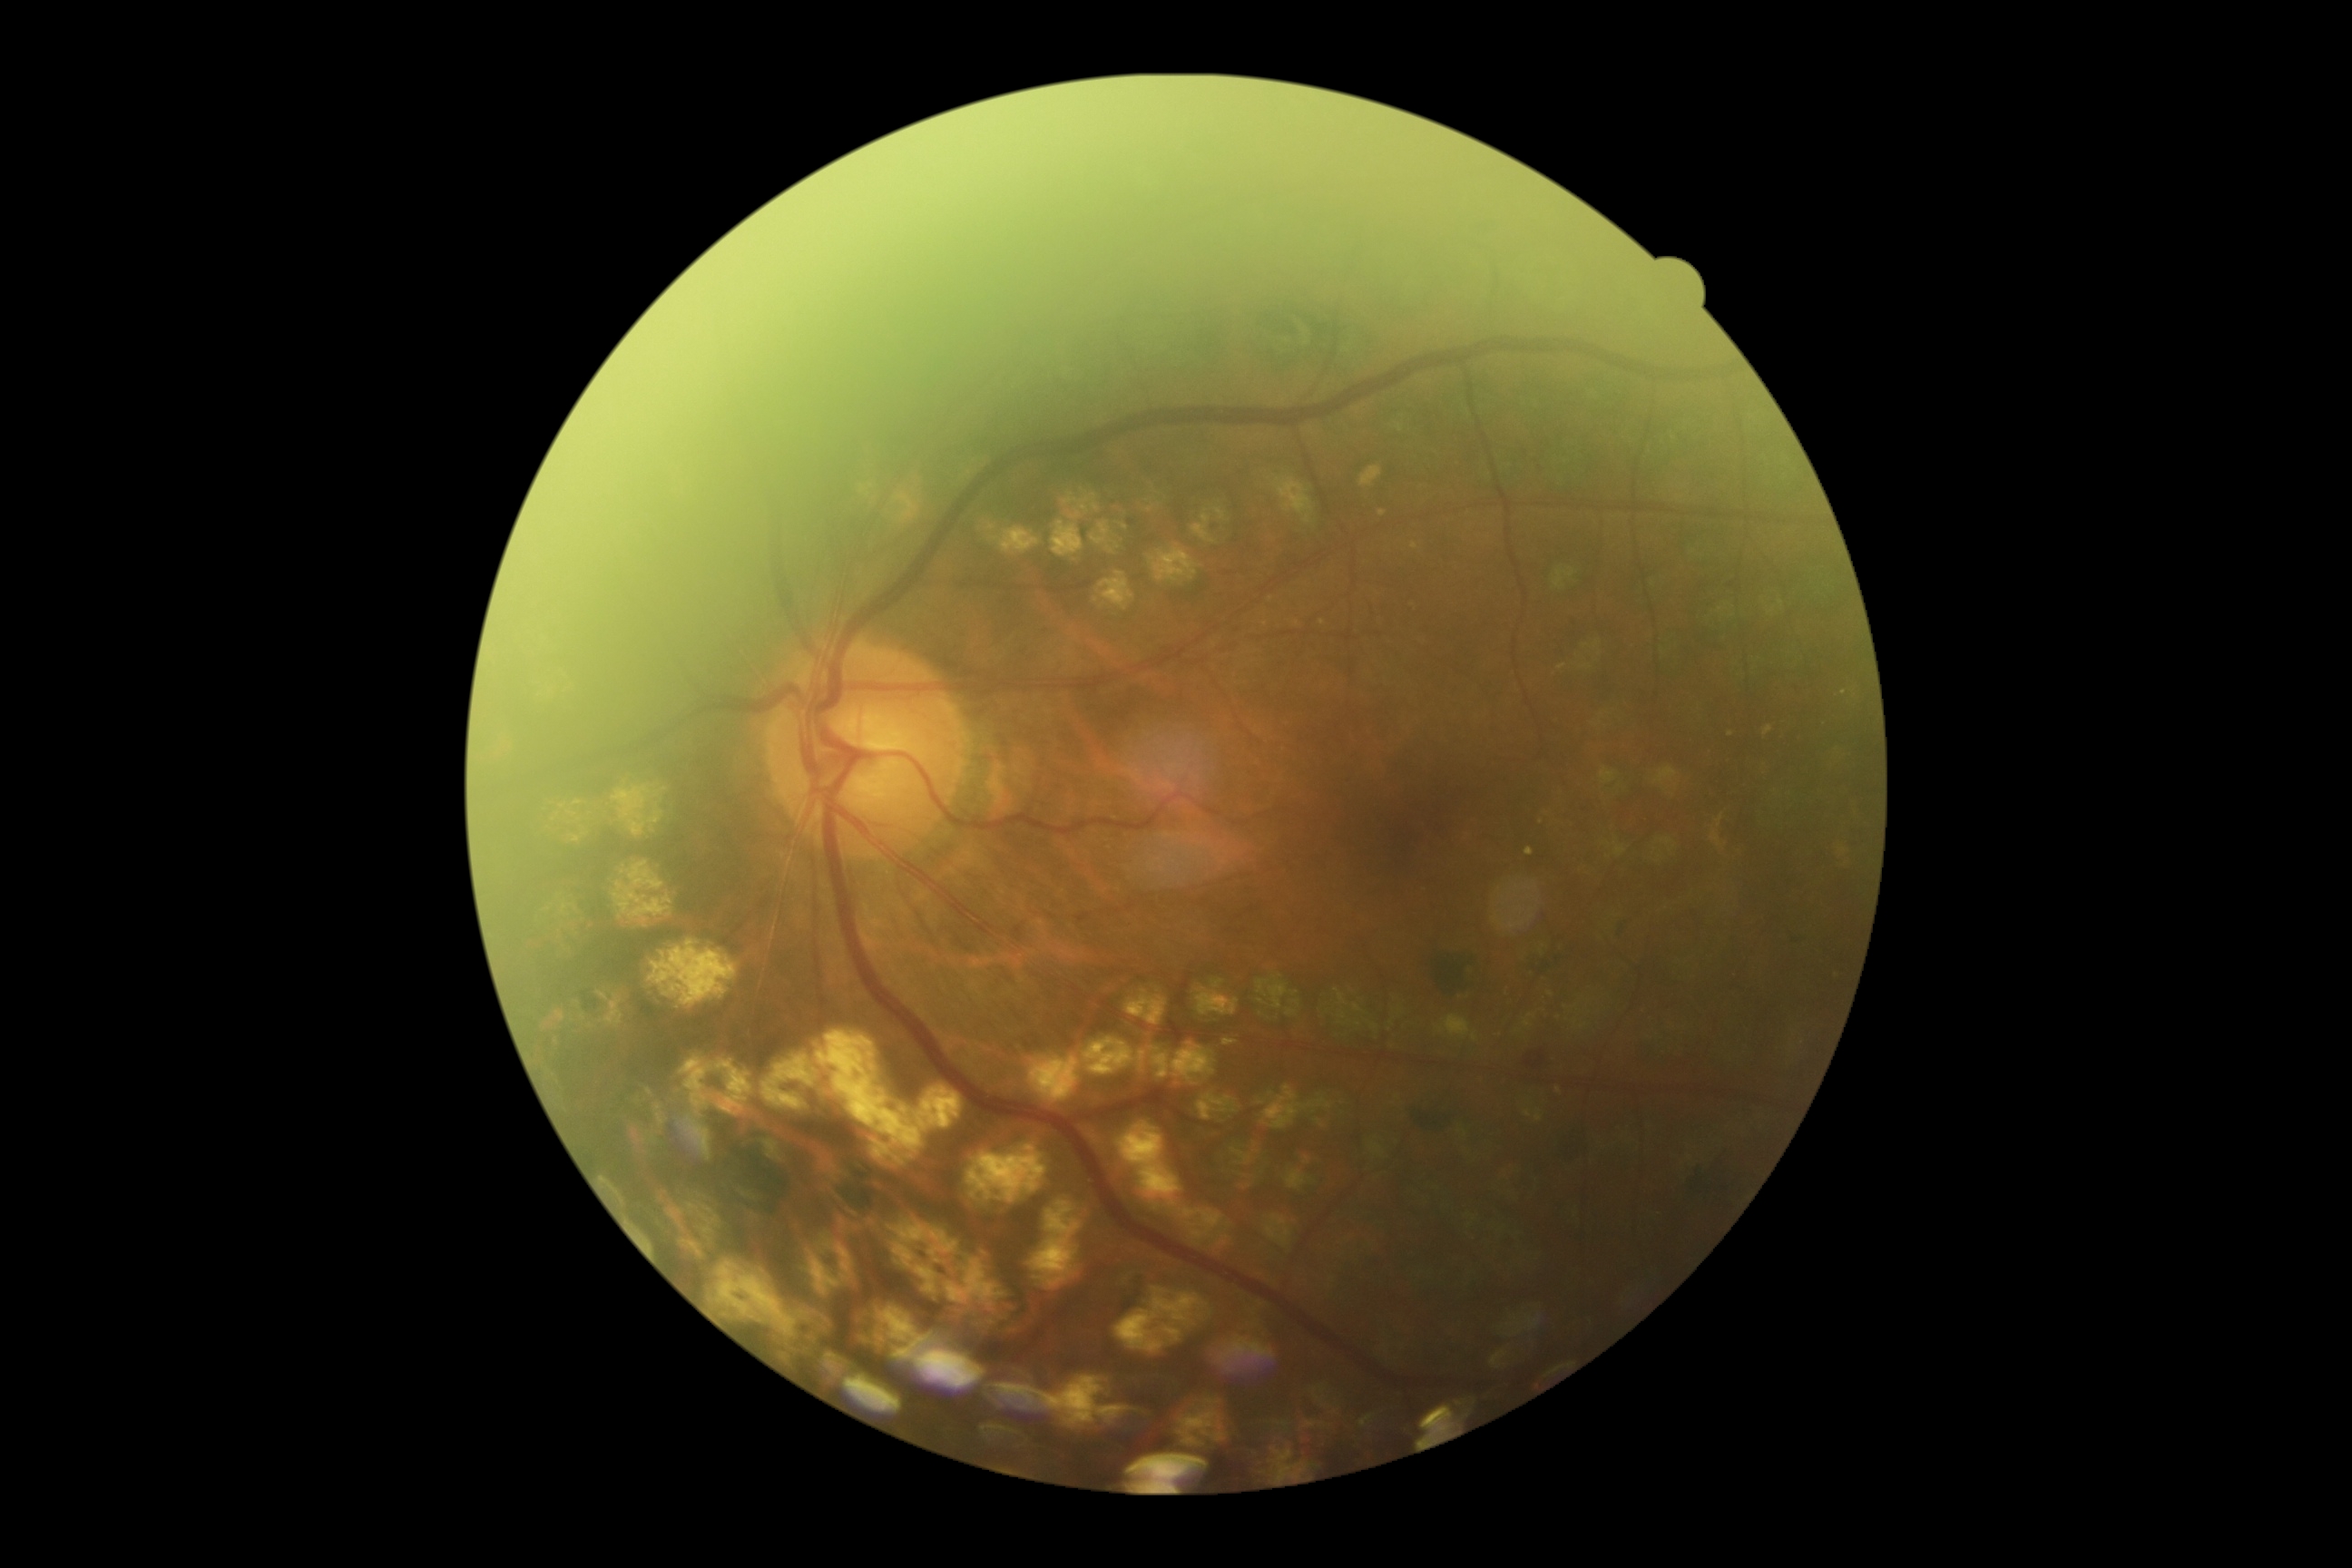 DR is moderate NPDR (grade 2).